Image size 240x240. Optic disc region crop — 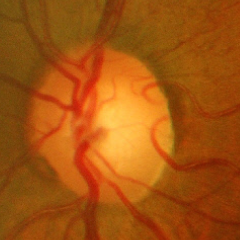 There is evidence of severe glaucomatous damage.